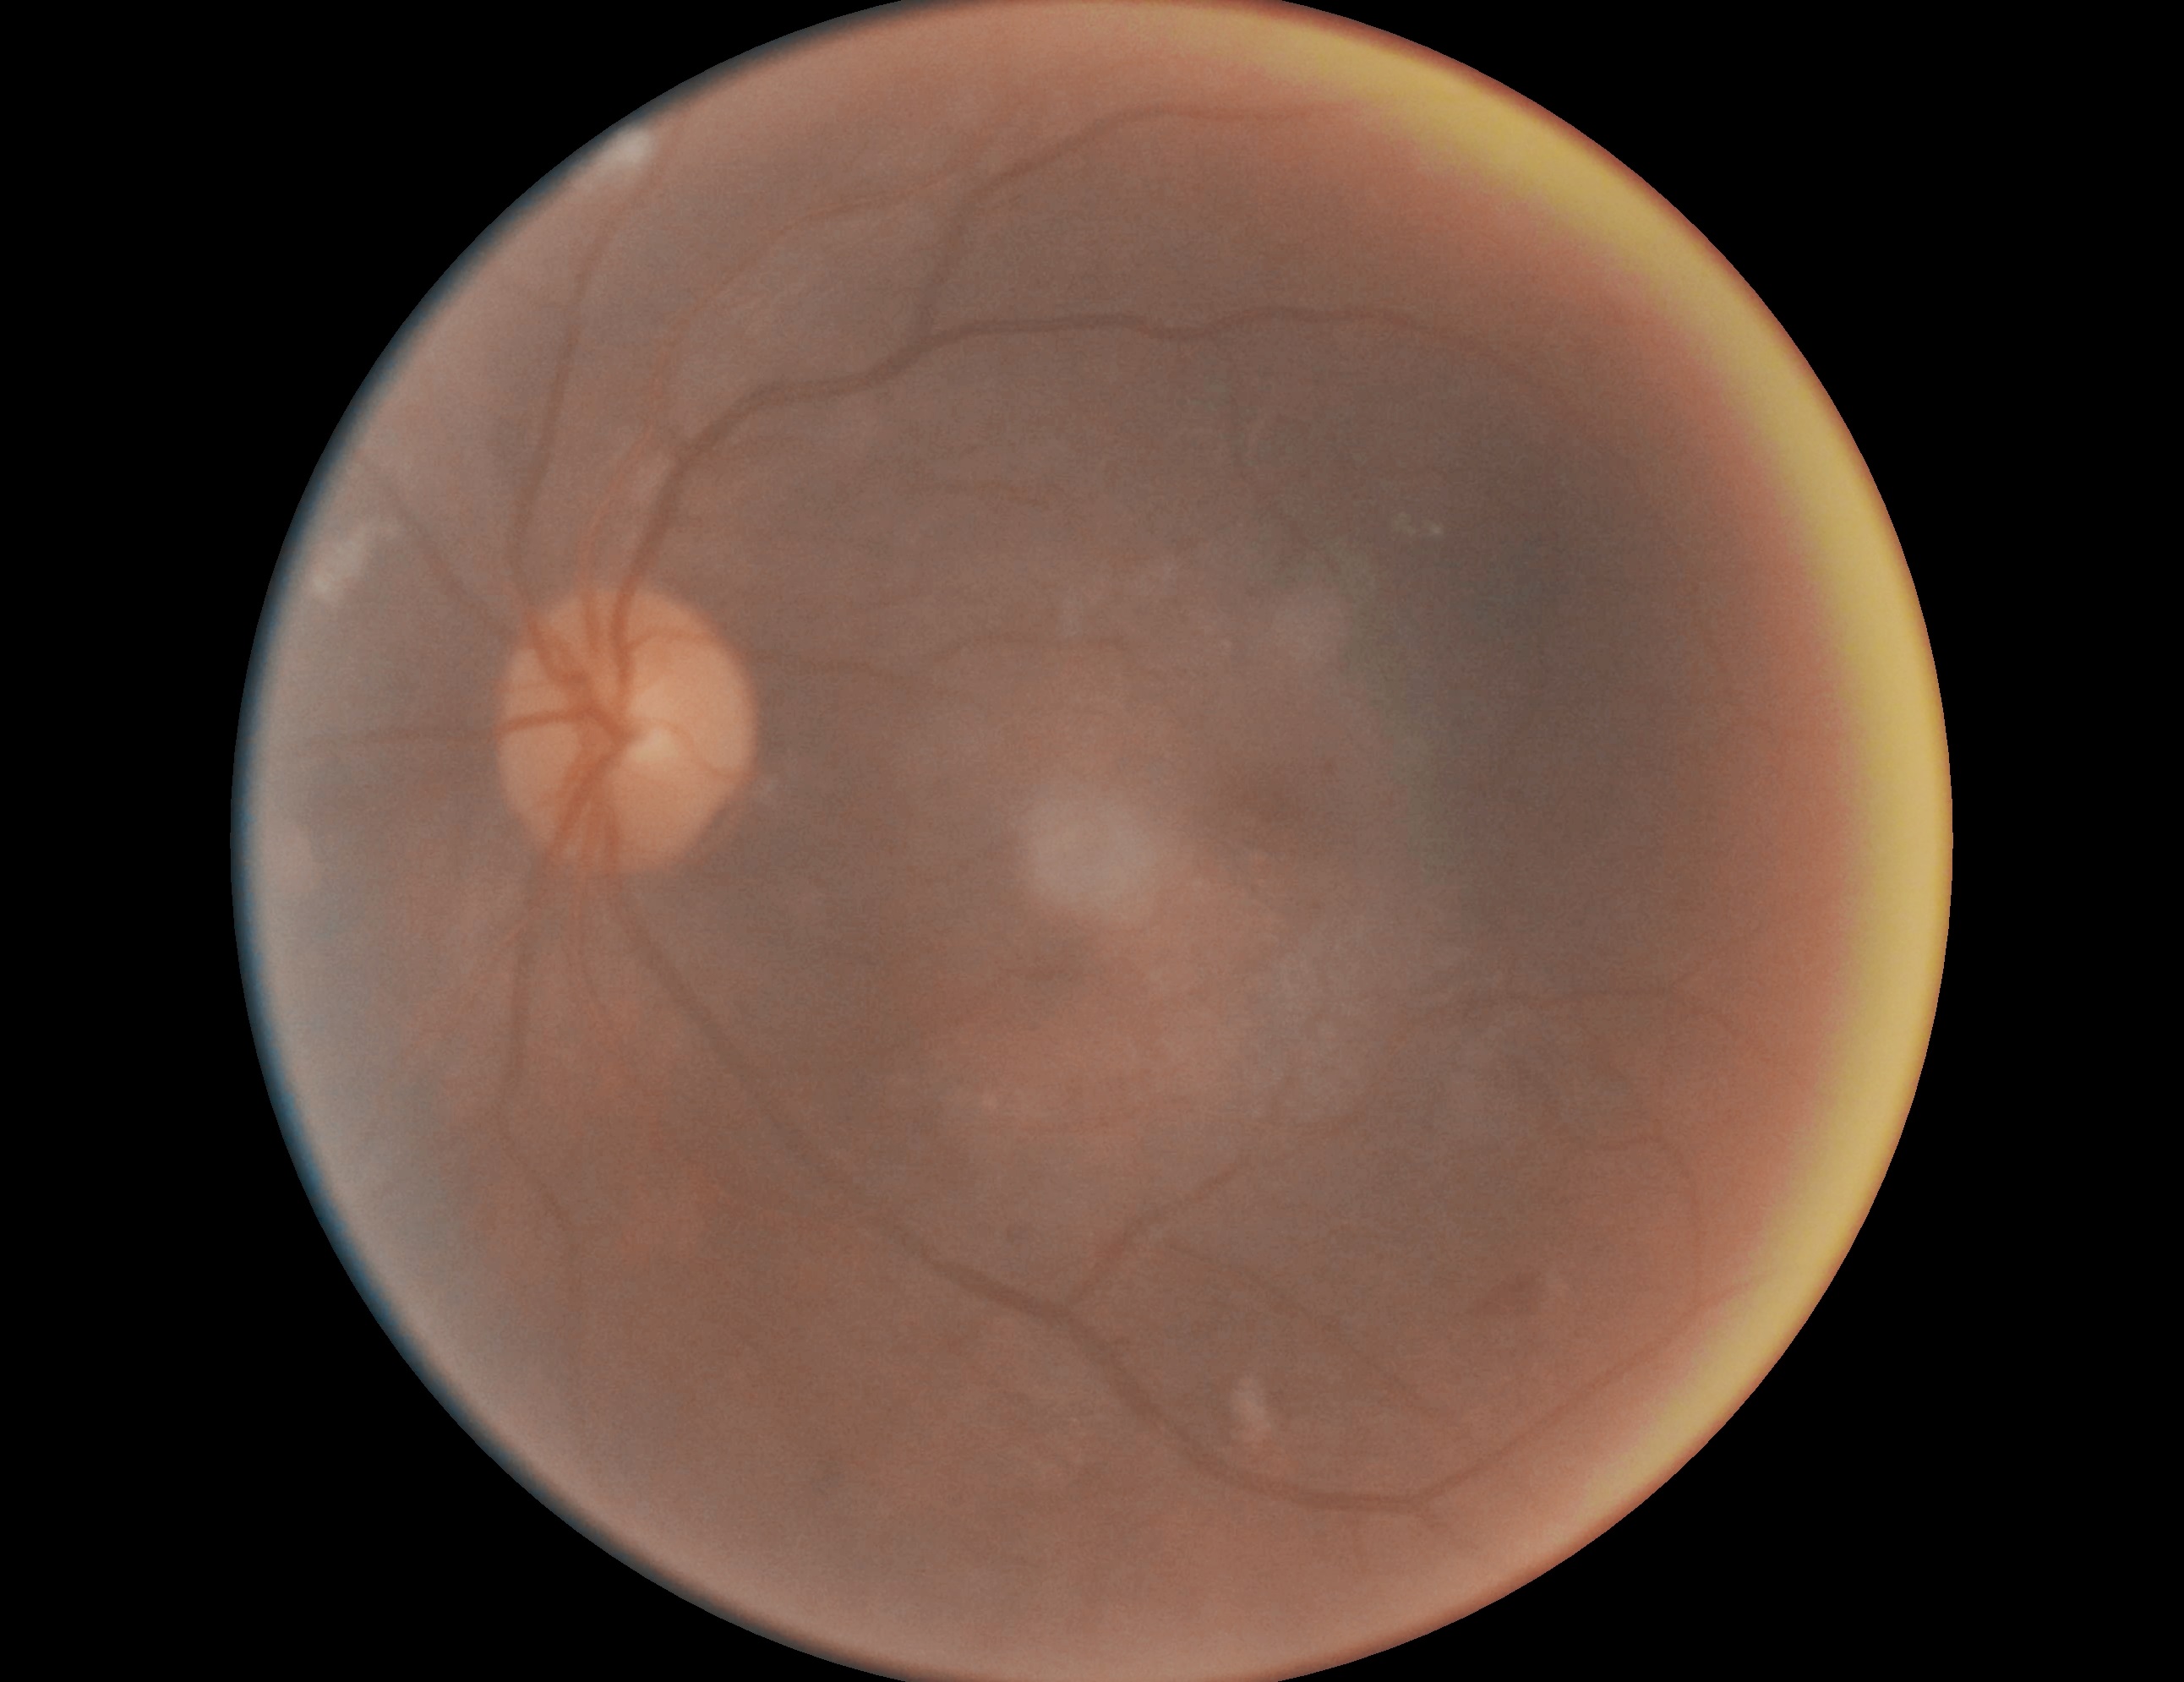
DR stage: grade 2.